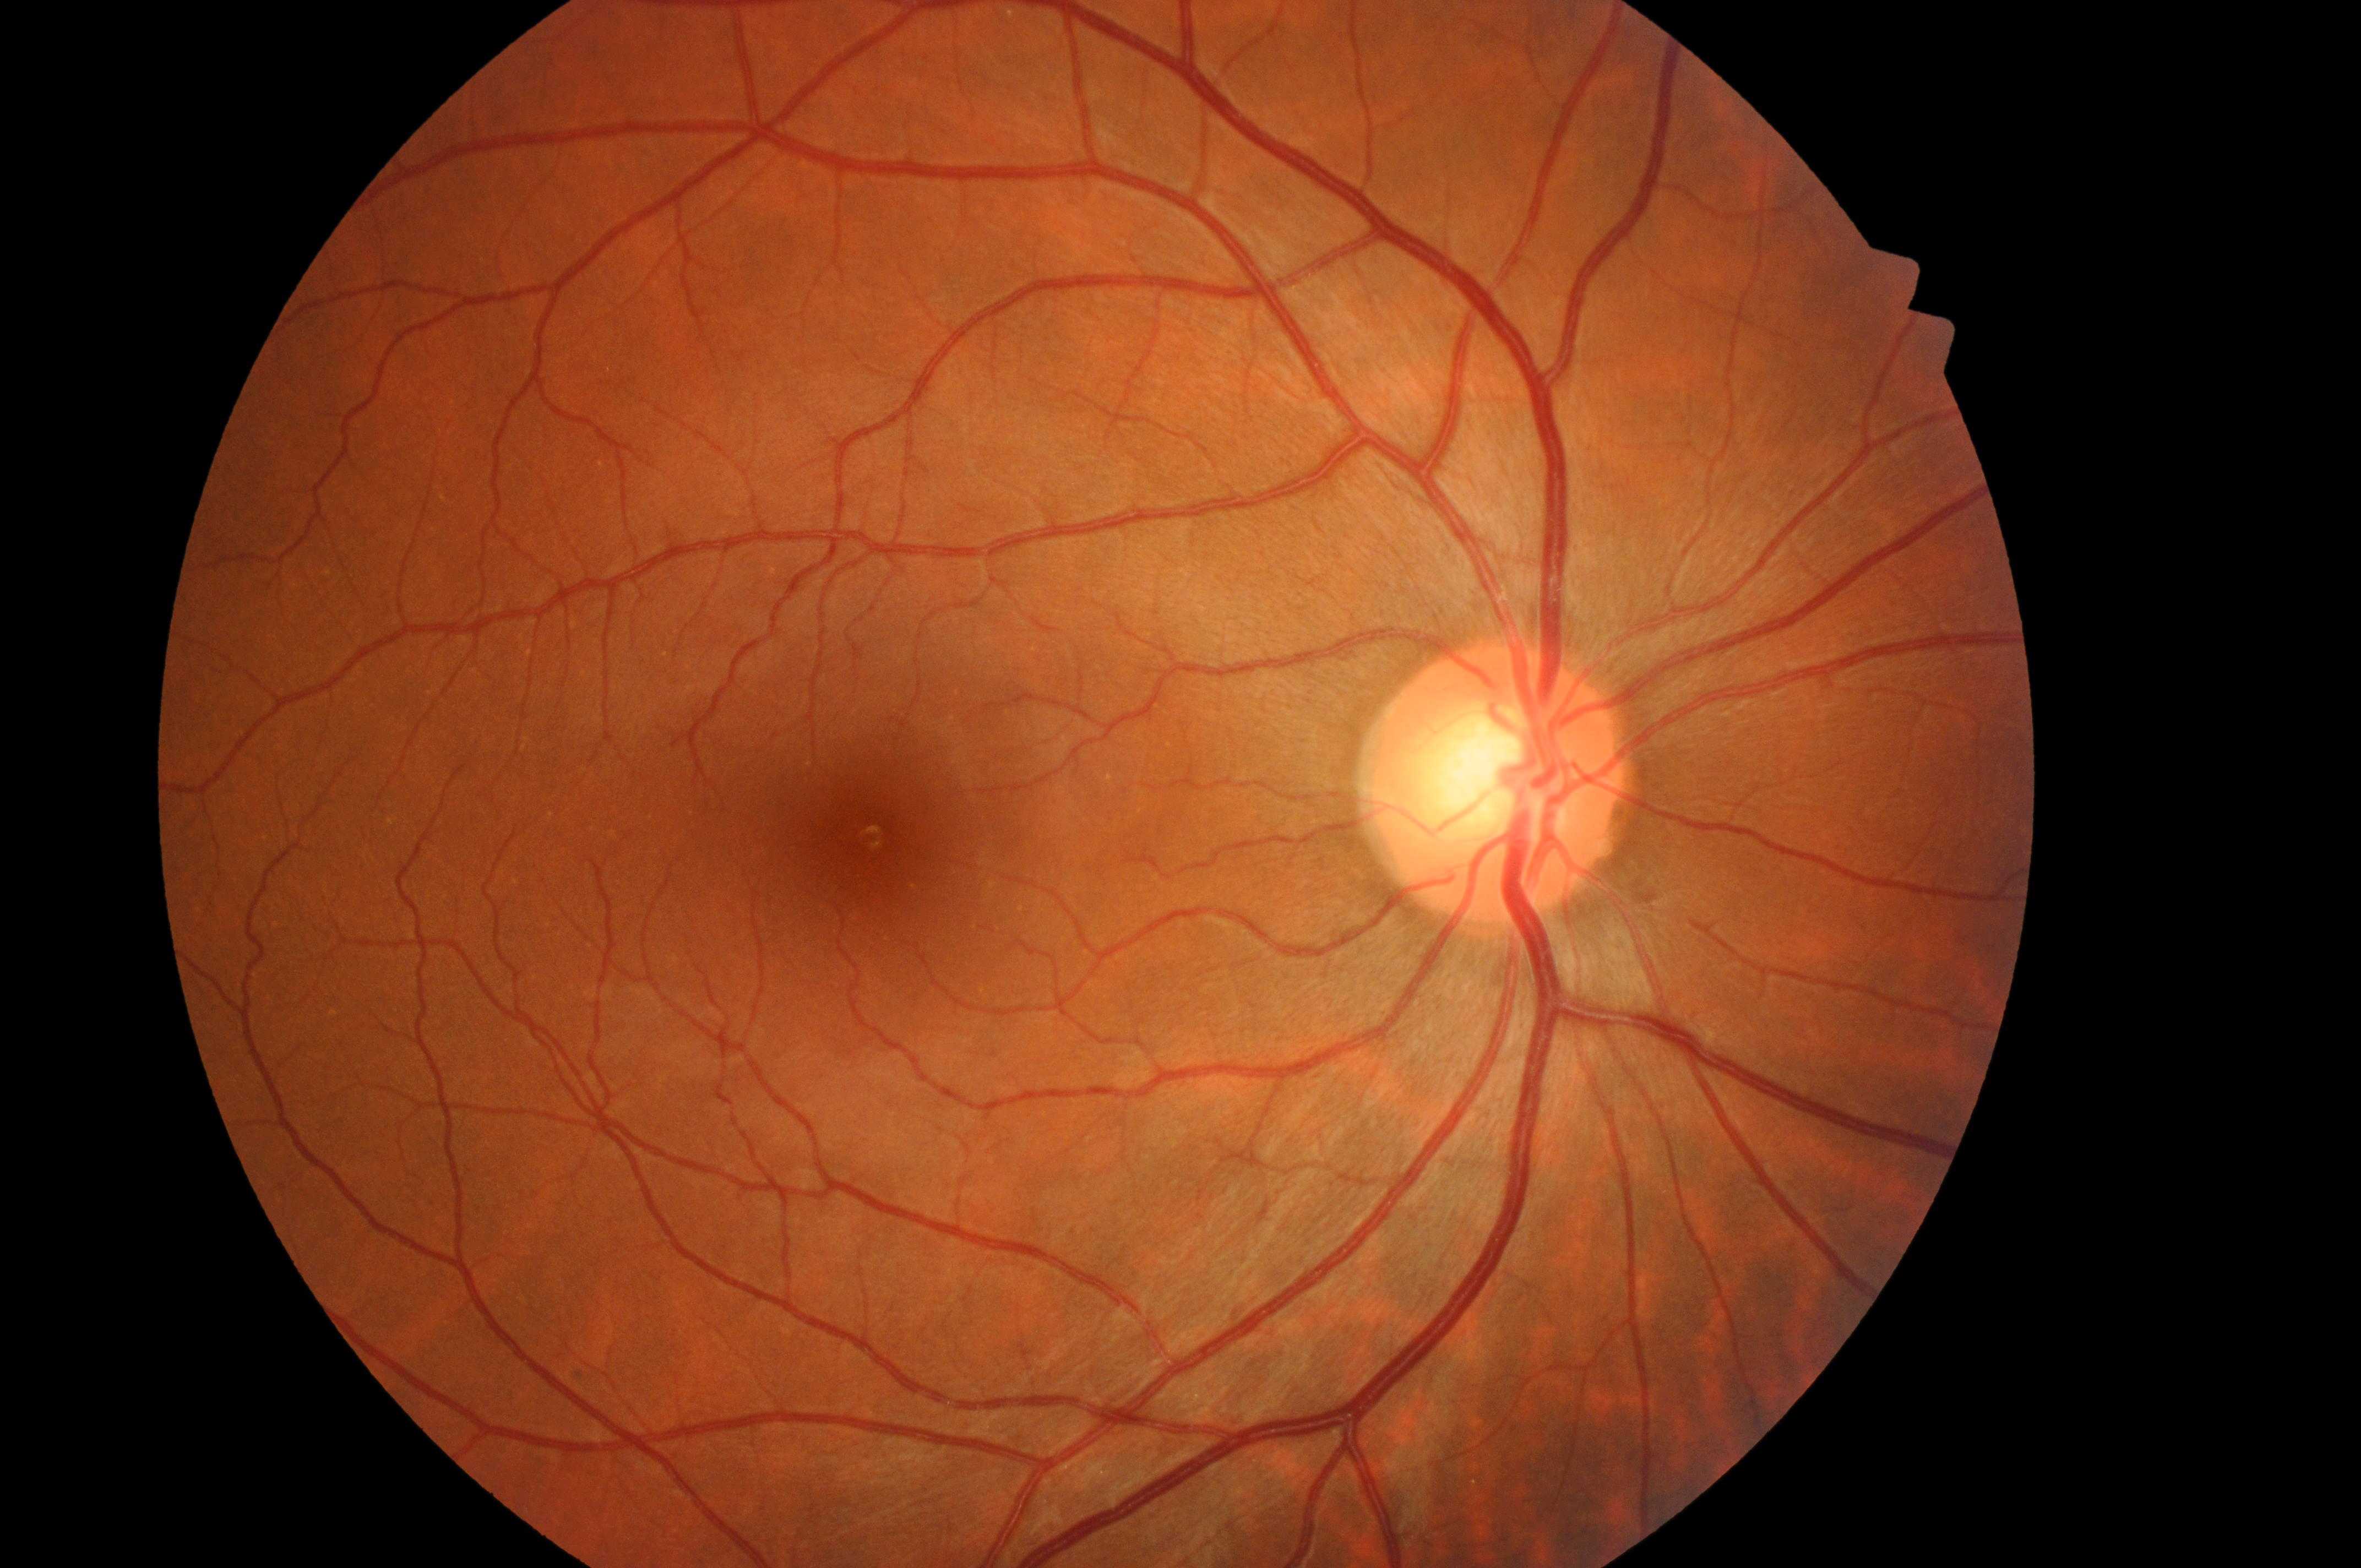

– fovea center · (871,841)
– optic disc center · (1493,800)
– diabetic retinopathy (DR) · 0
– laterality · right eye
– diabetic macular edema (DME) · 0/2